Wide-field fundus image from infant ROP screening · captured with the Clarity RetCam 3 (130° field of view) · 640 by 480 pixels:
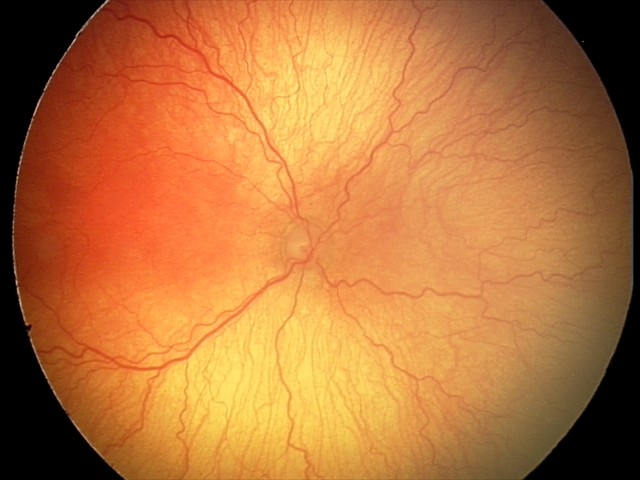

Assessment: aggressive retinopathy of prematurity (A-ROP)
plus disease: present